1470x1137, FOV: 45 degrees, CFP — 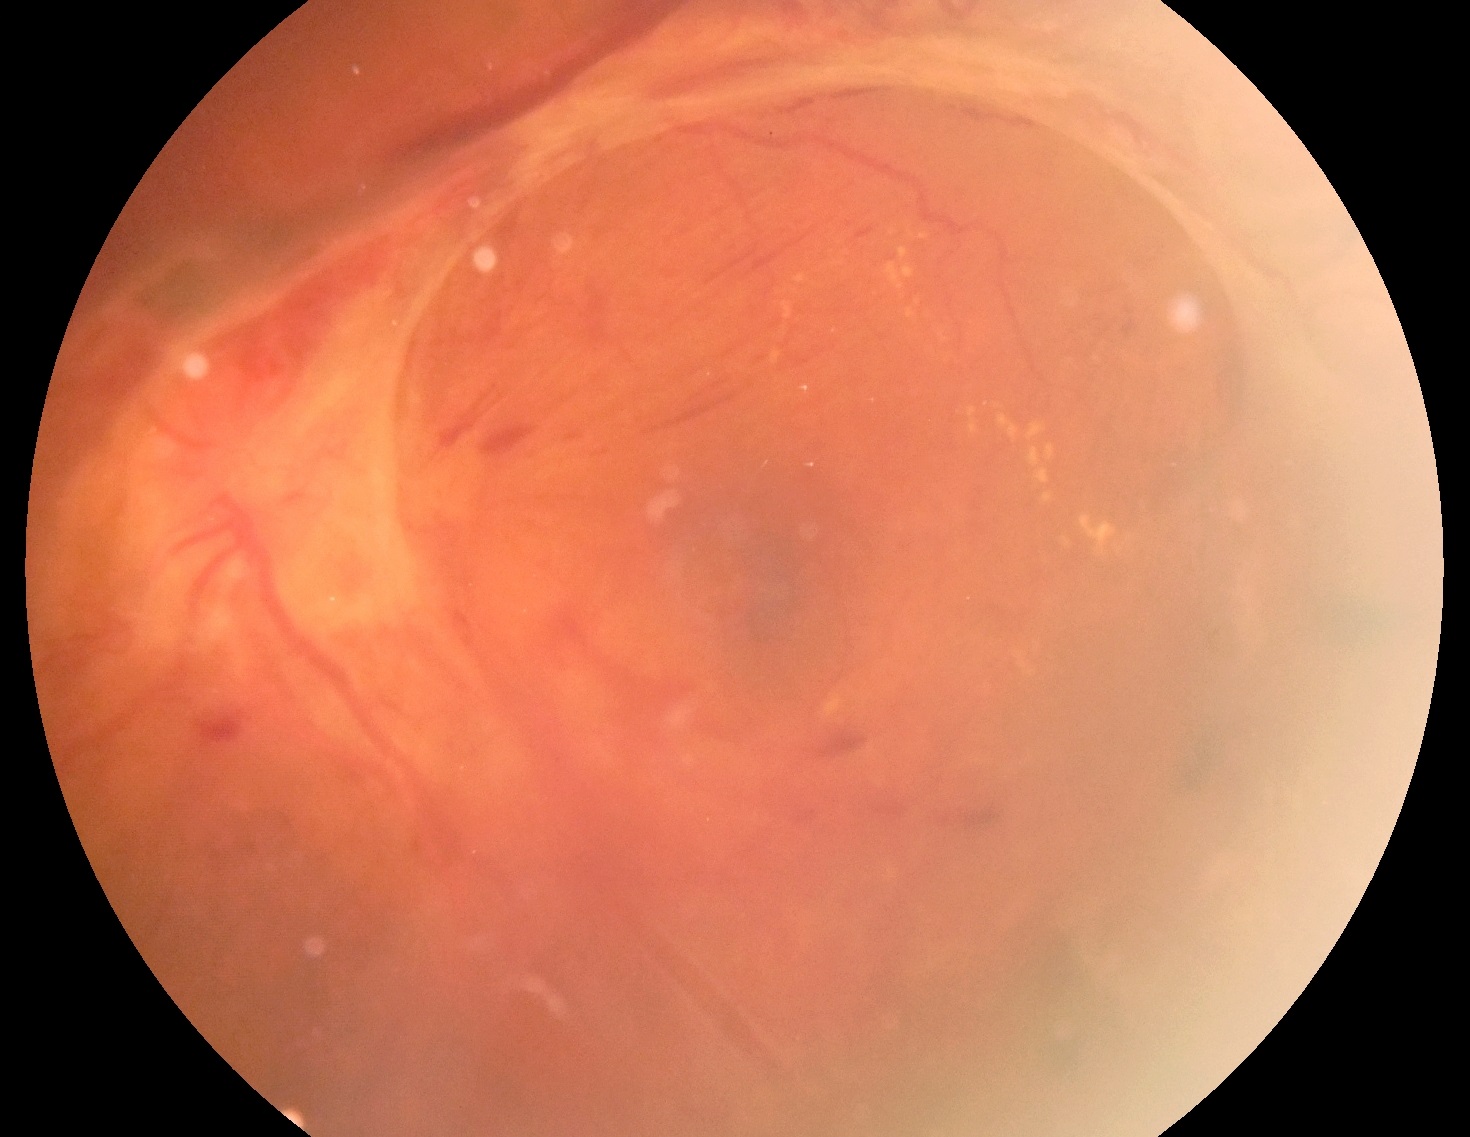

diabetic retinopathy grade=4 (PDR).